NIDEK AFC-230
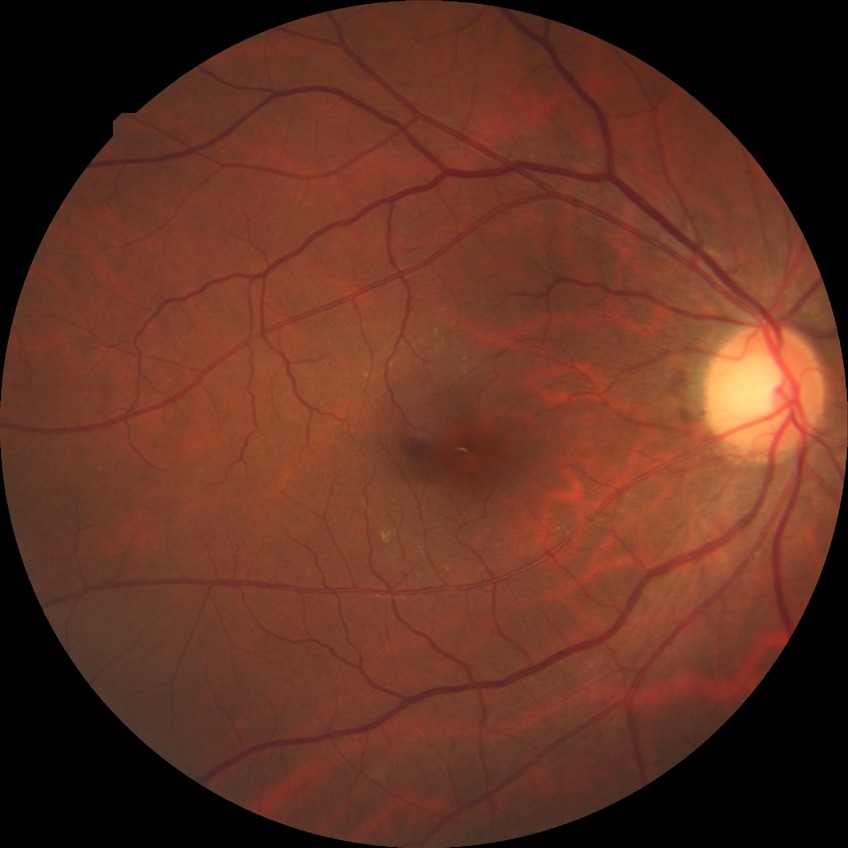 Davis stage: NDR.